Acquired on the Clarity RetCam 3; wide-field fundus photograph from neonatal ROP screening — 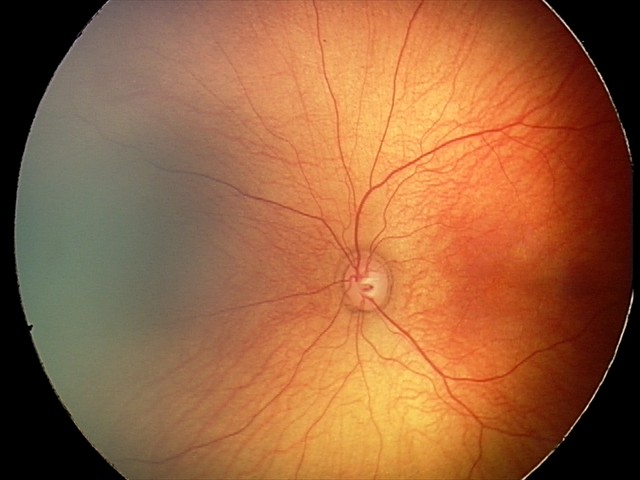

Normal screening examination.